848 x 848 pixels · modified Davis grading · NIDEK AFC-230 — 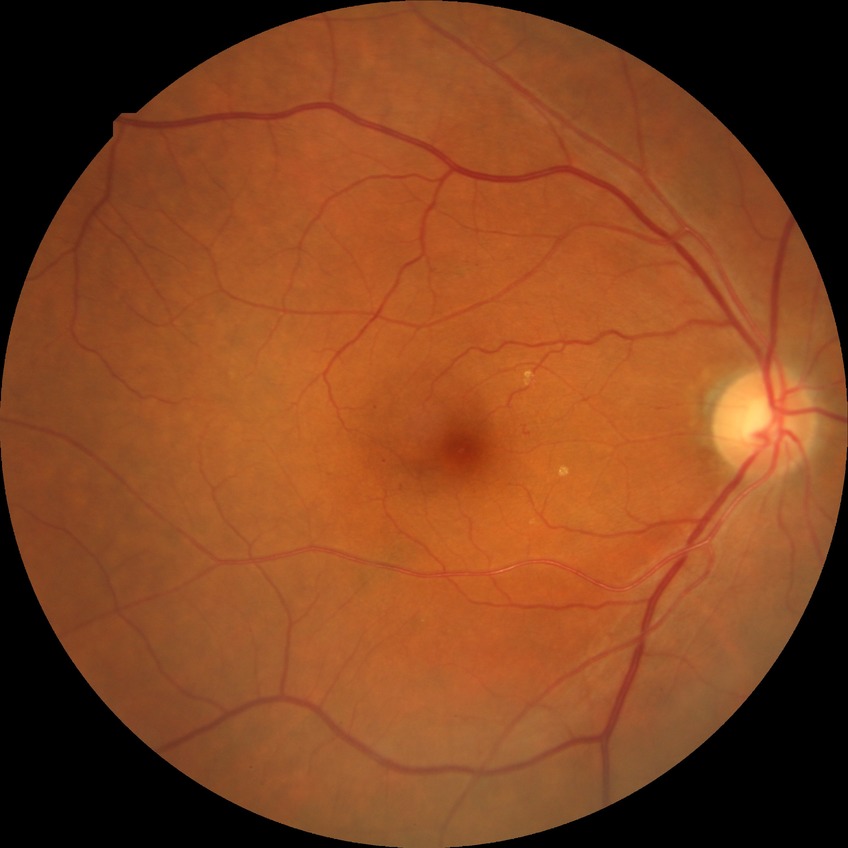 Diabetic retinopathy grade is simple diabetic retinopathy.